Wide-field retinal mosaic image
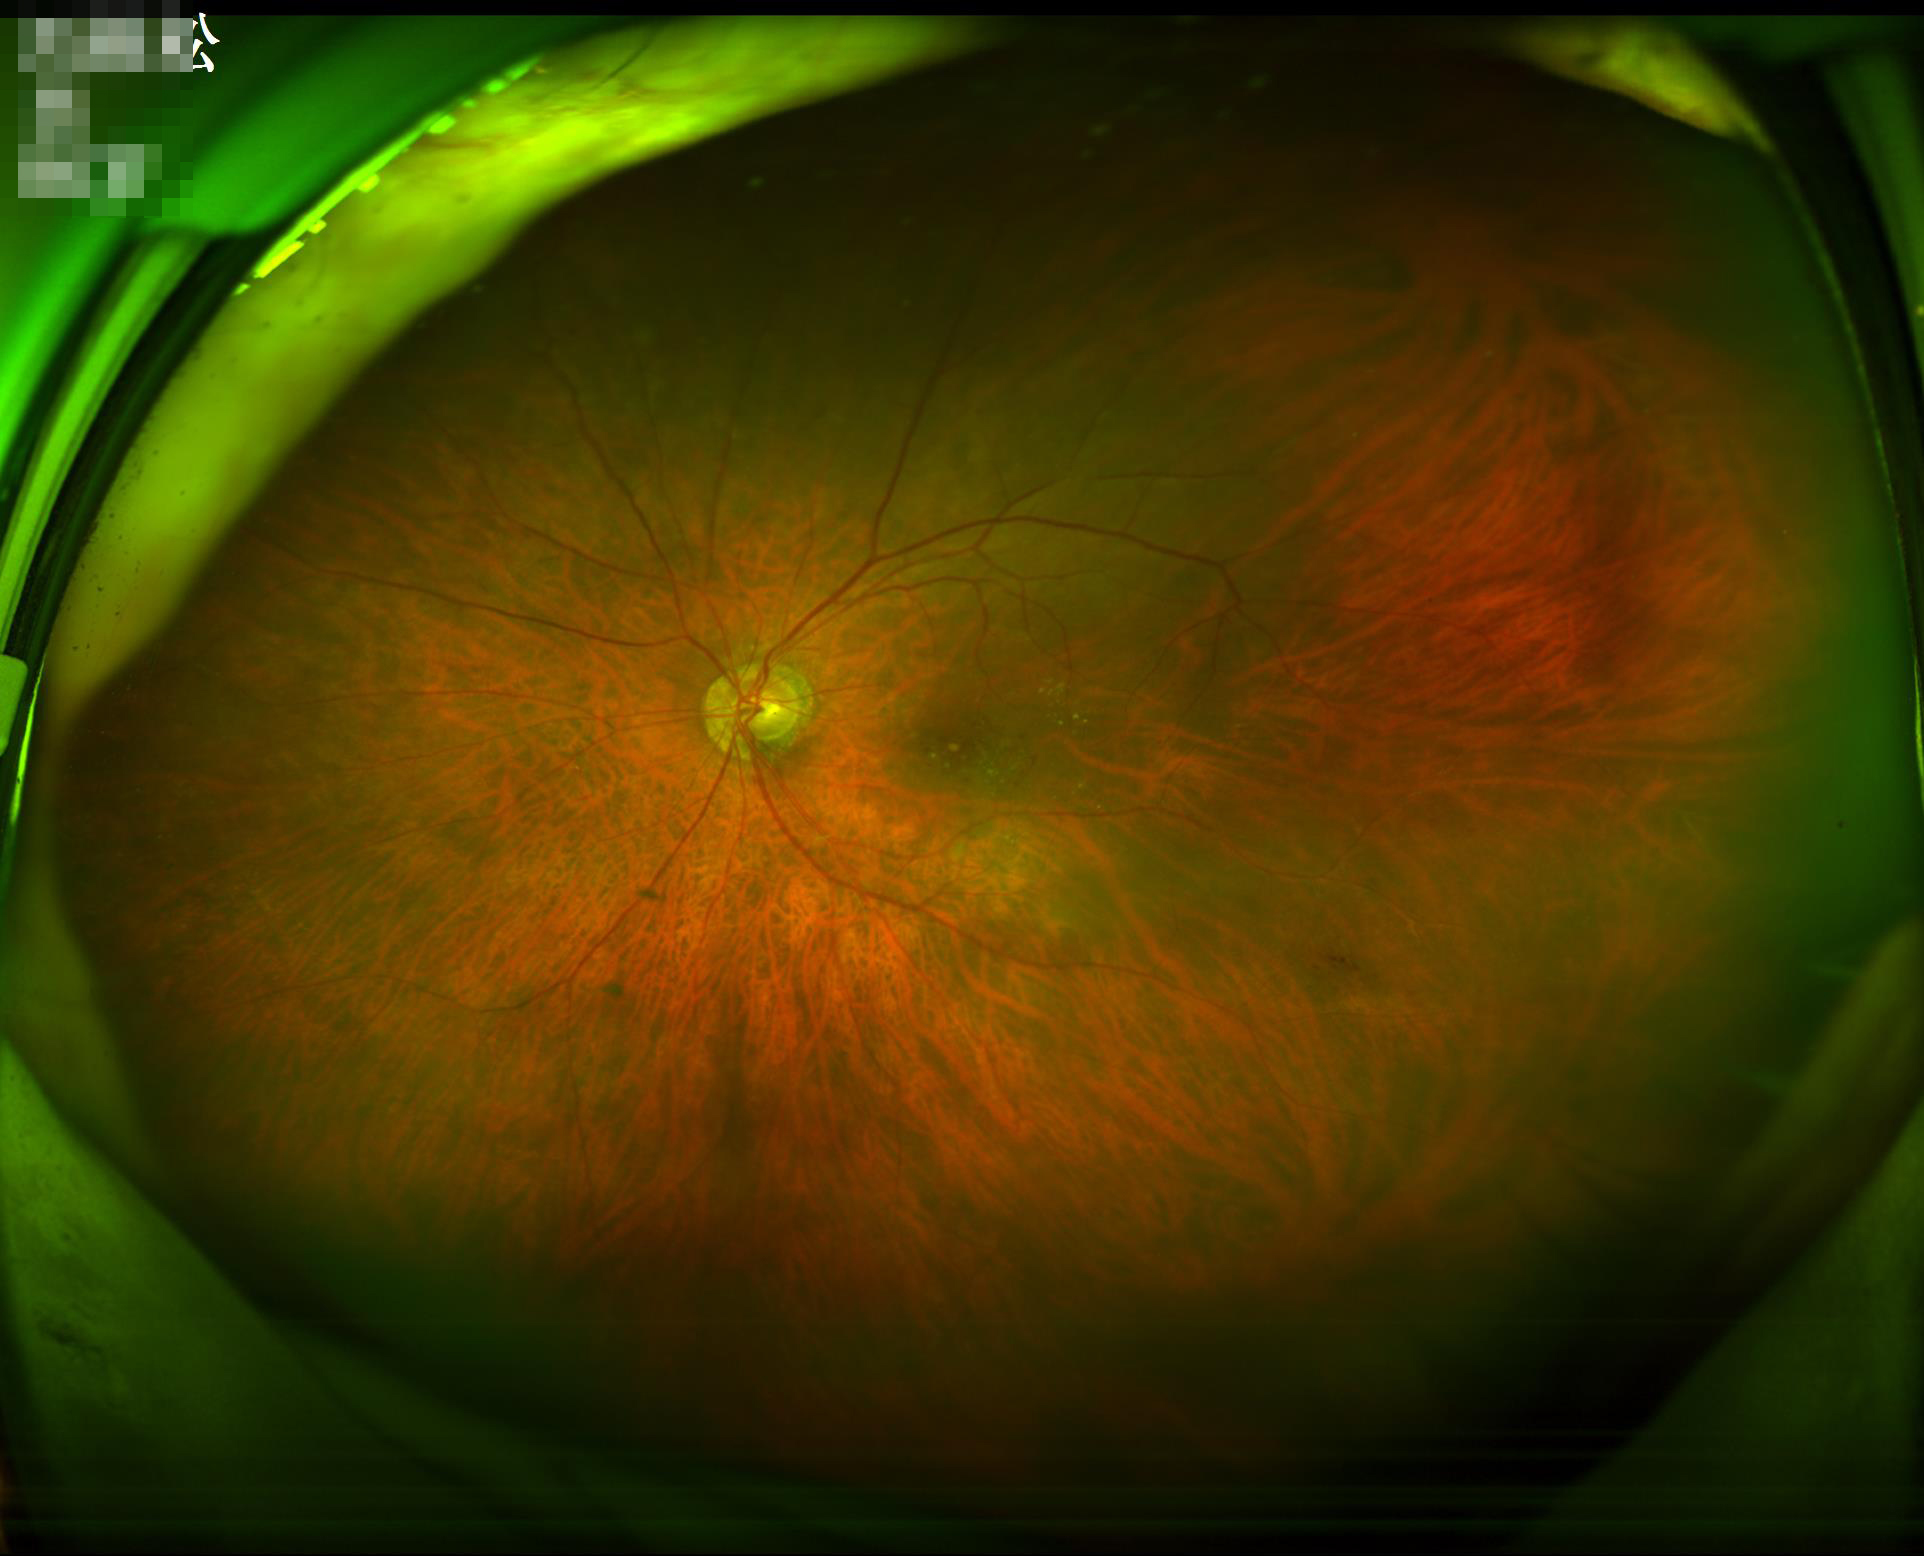
Image quality assessment:
- sharpness: sharp
- illumination/color: even
- contrast: satisfactory
- overall: satisfactory